Pediatric retinal photograph (wide-field):
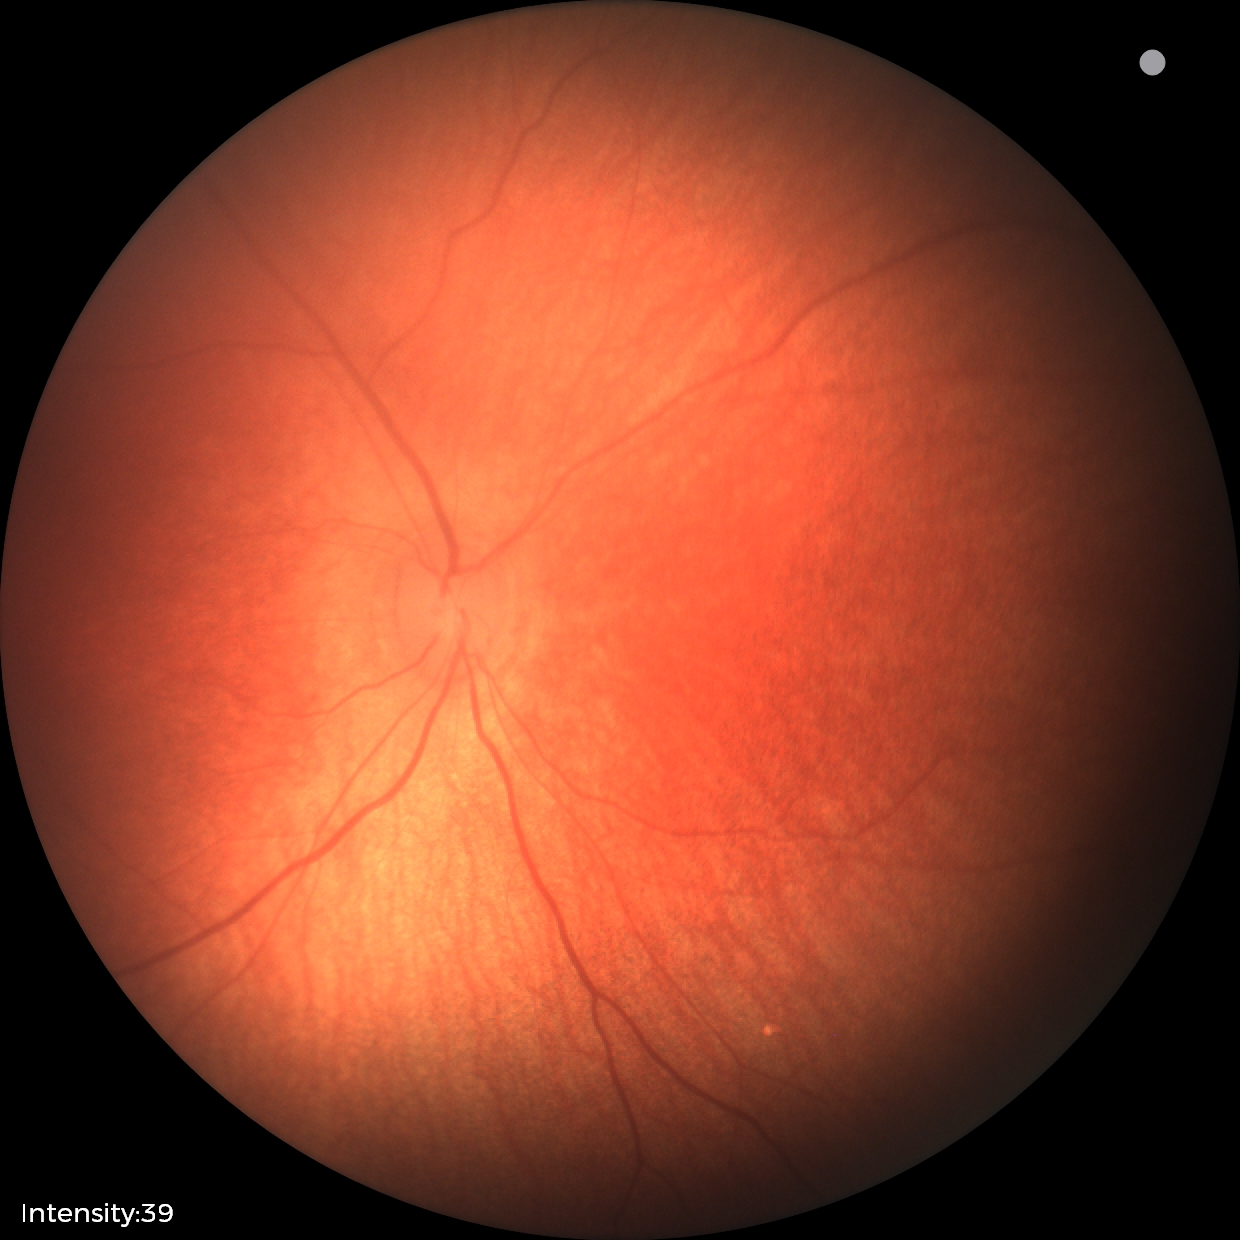 Diagnosis: normal retinal appearance